2352x1568px; 45° field of view; CFP.
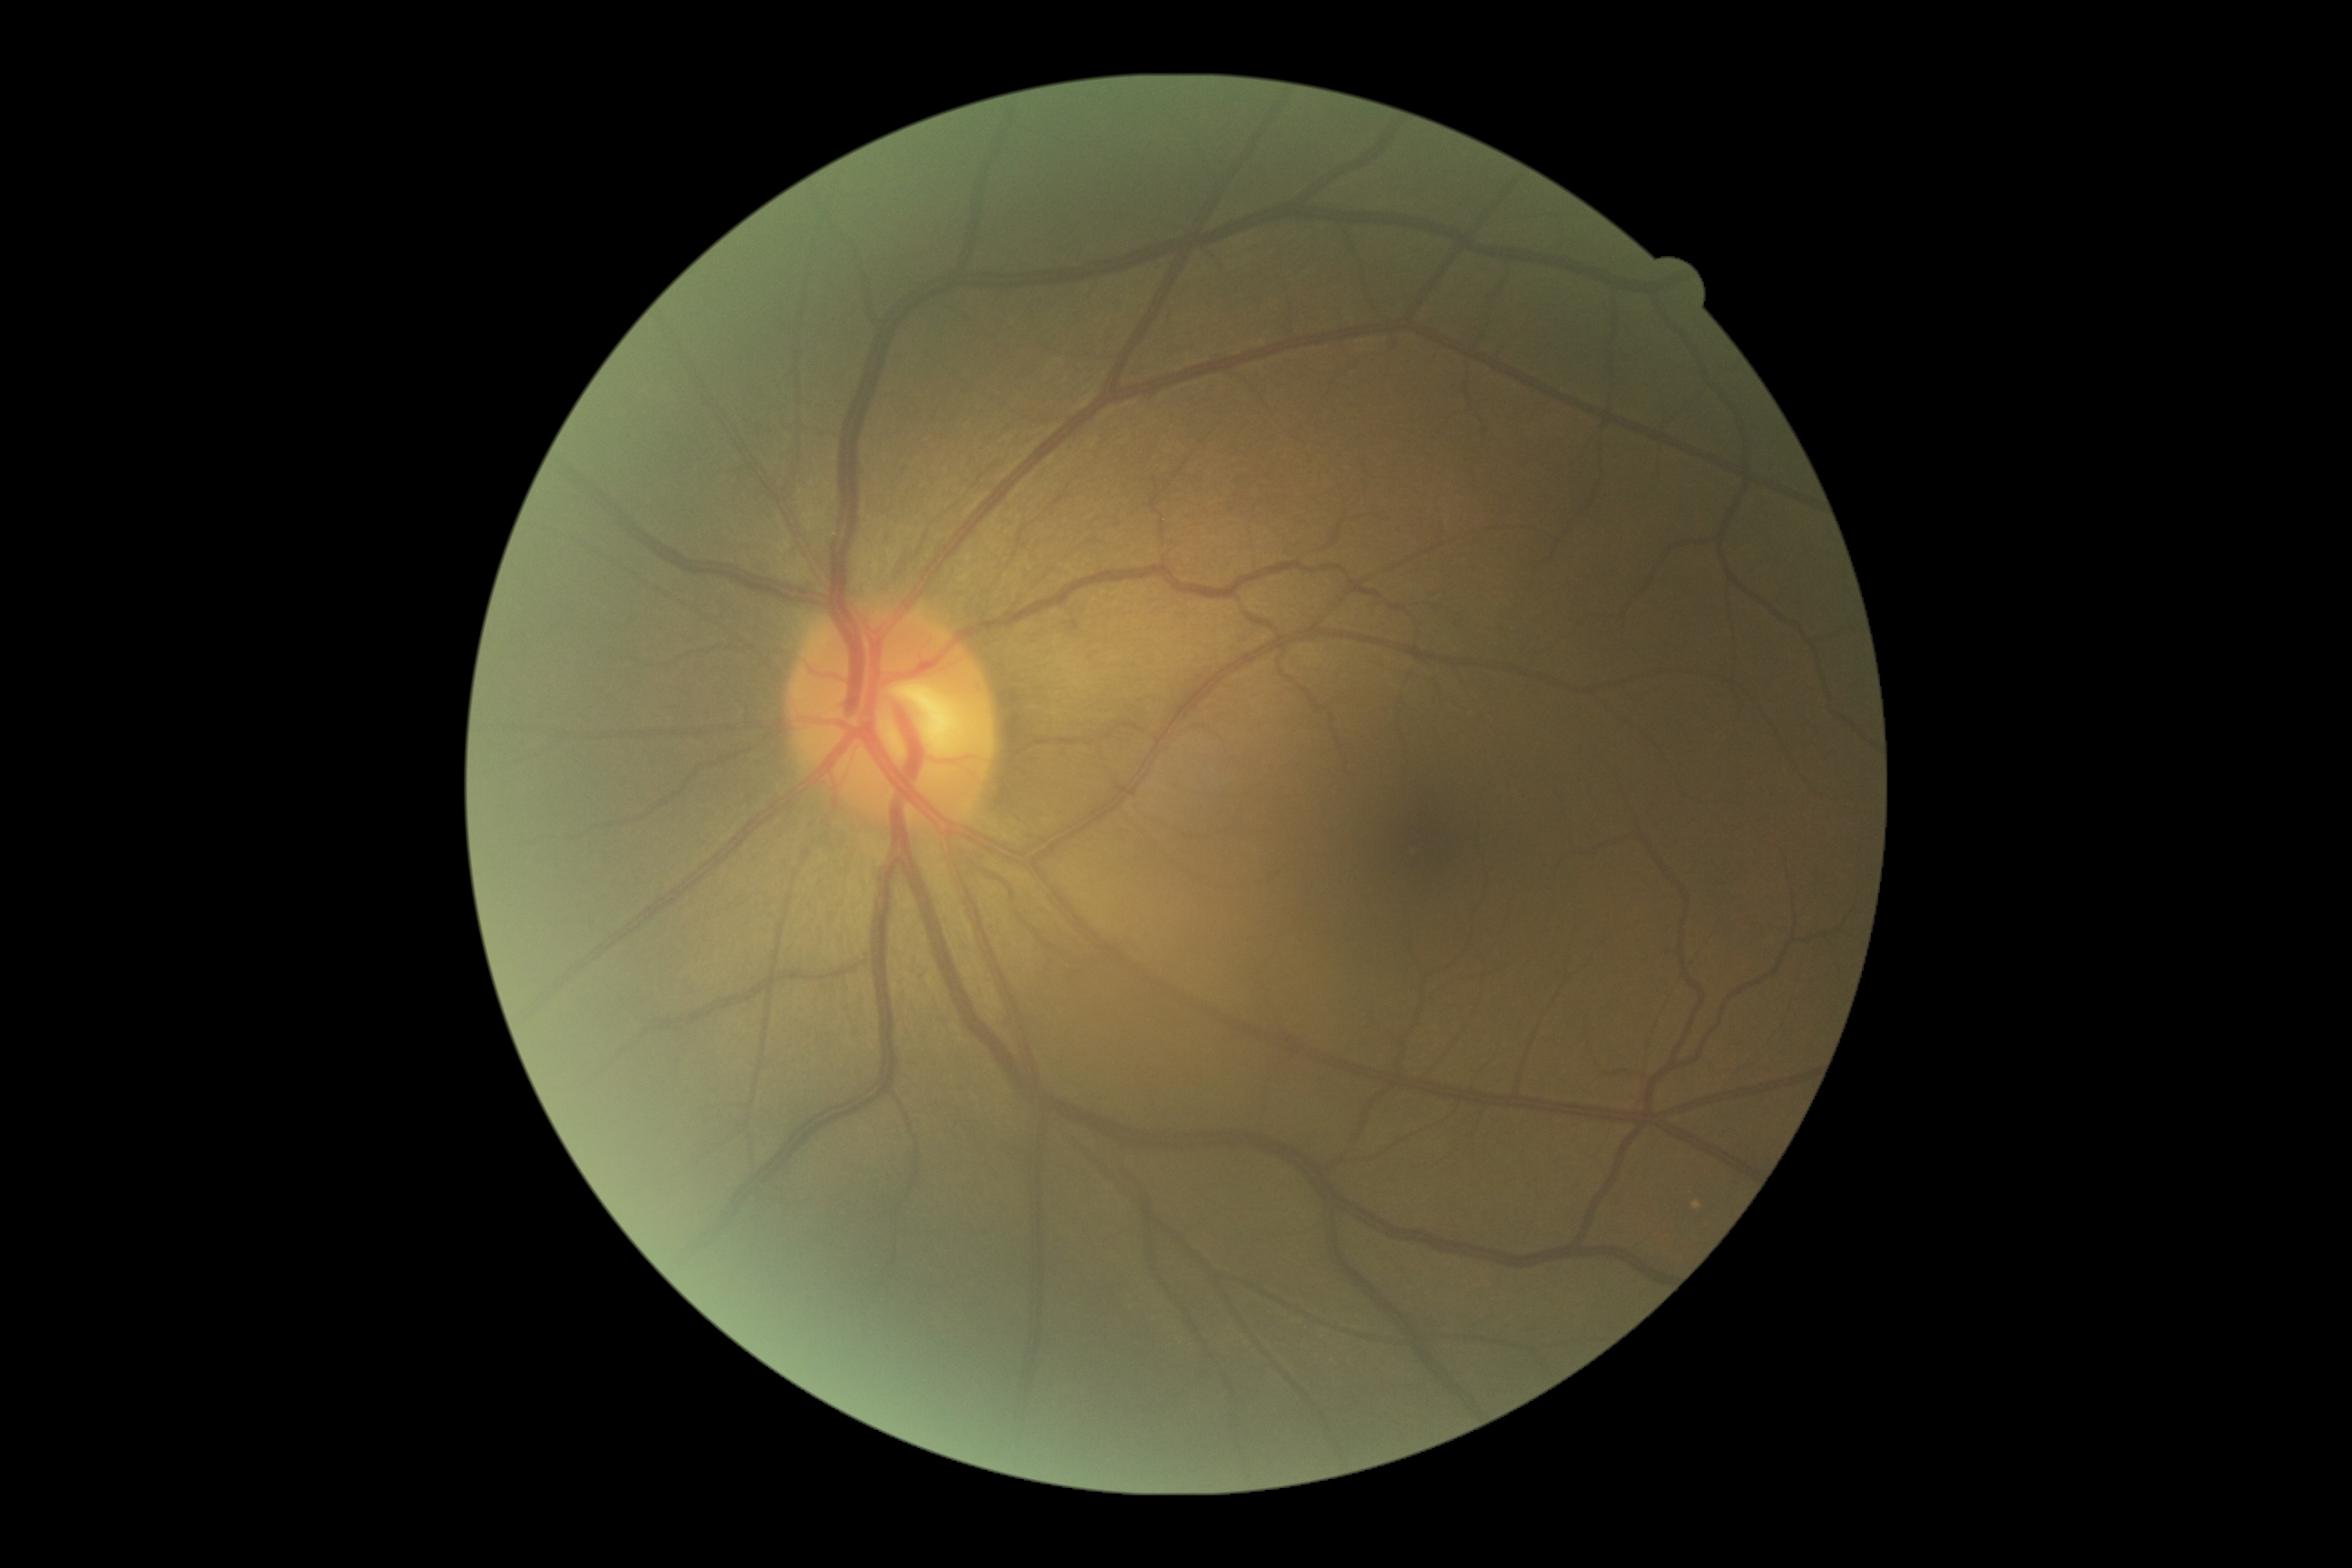
• diabetic retinopathy severity — grade 0 — no visible signs of diabetic retinopathy